2361x1568px · acquired with a Kowa VX-10α · pupil-dilated: 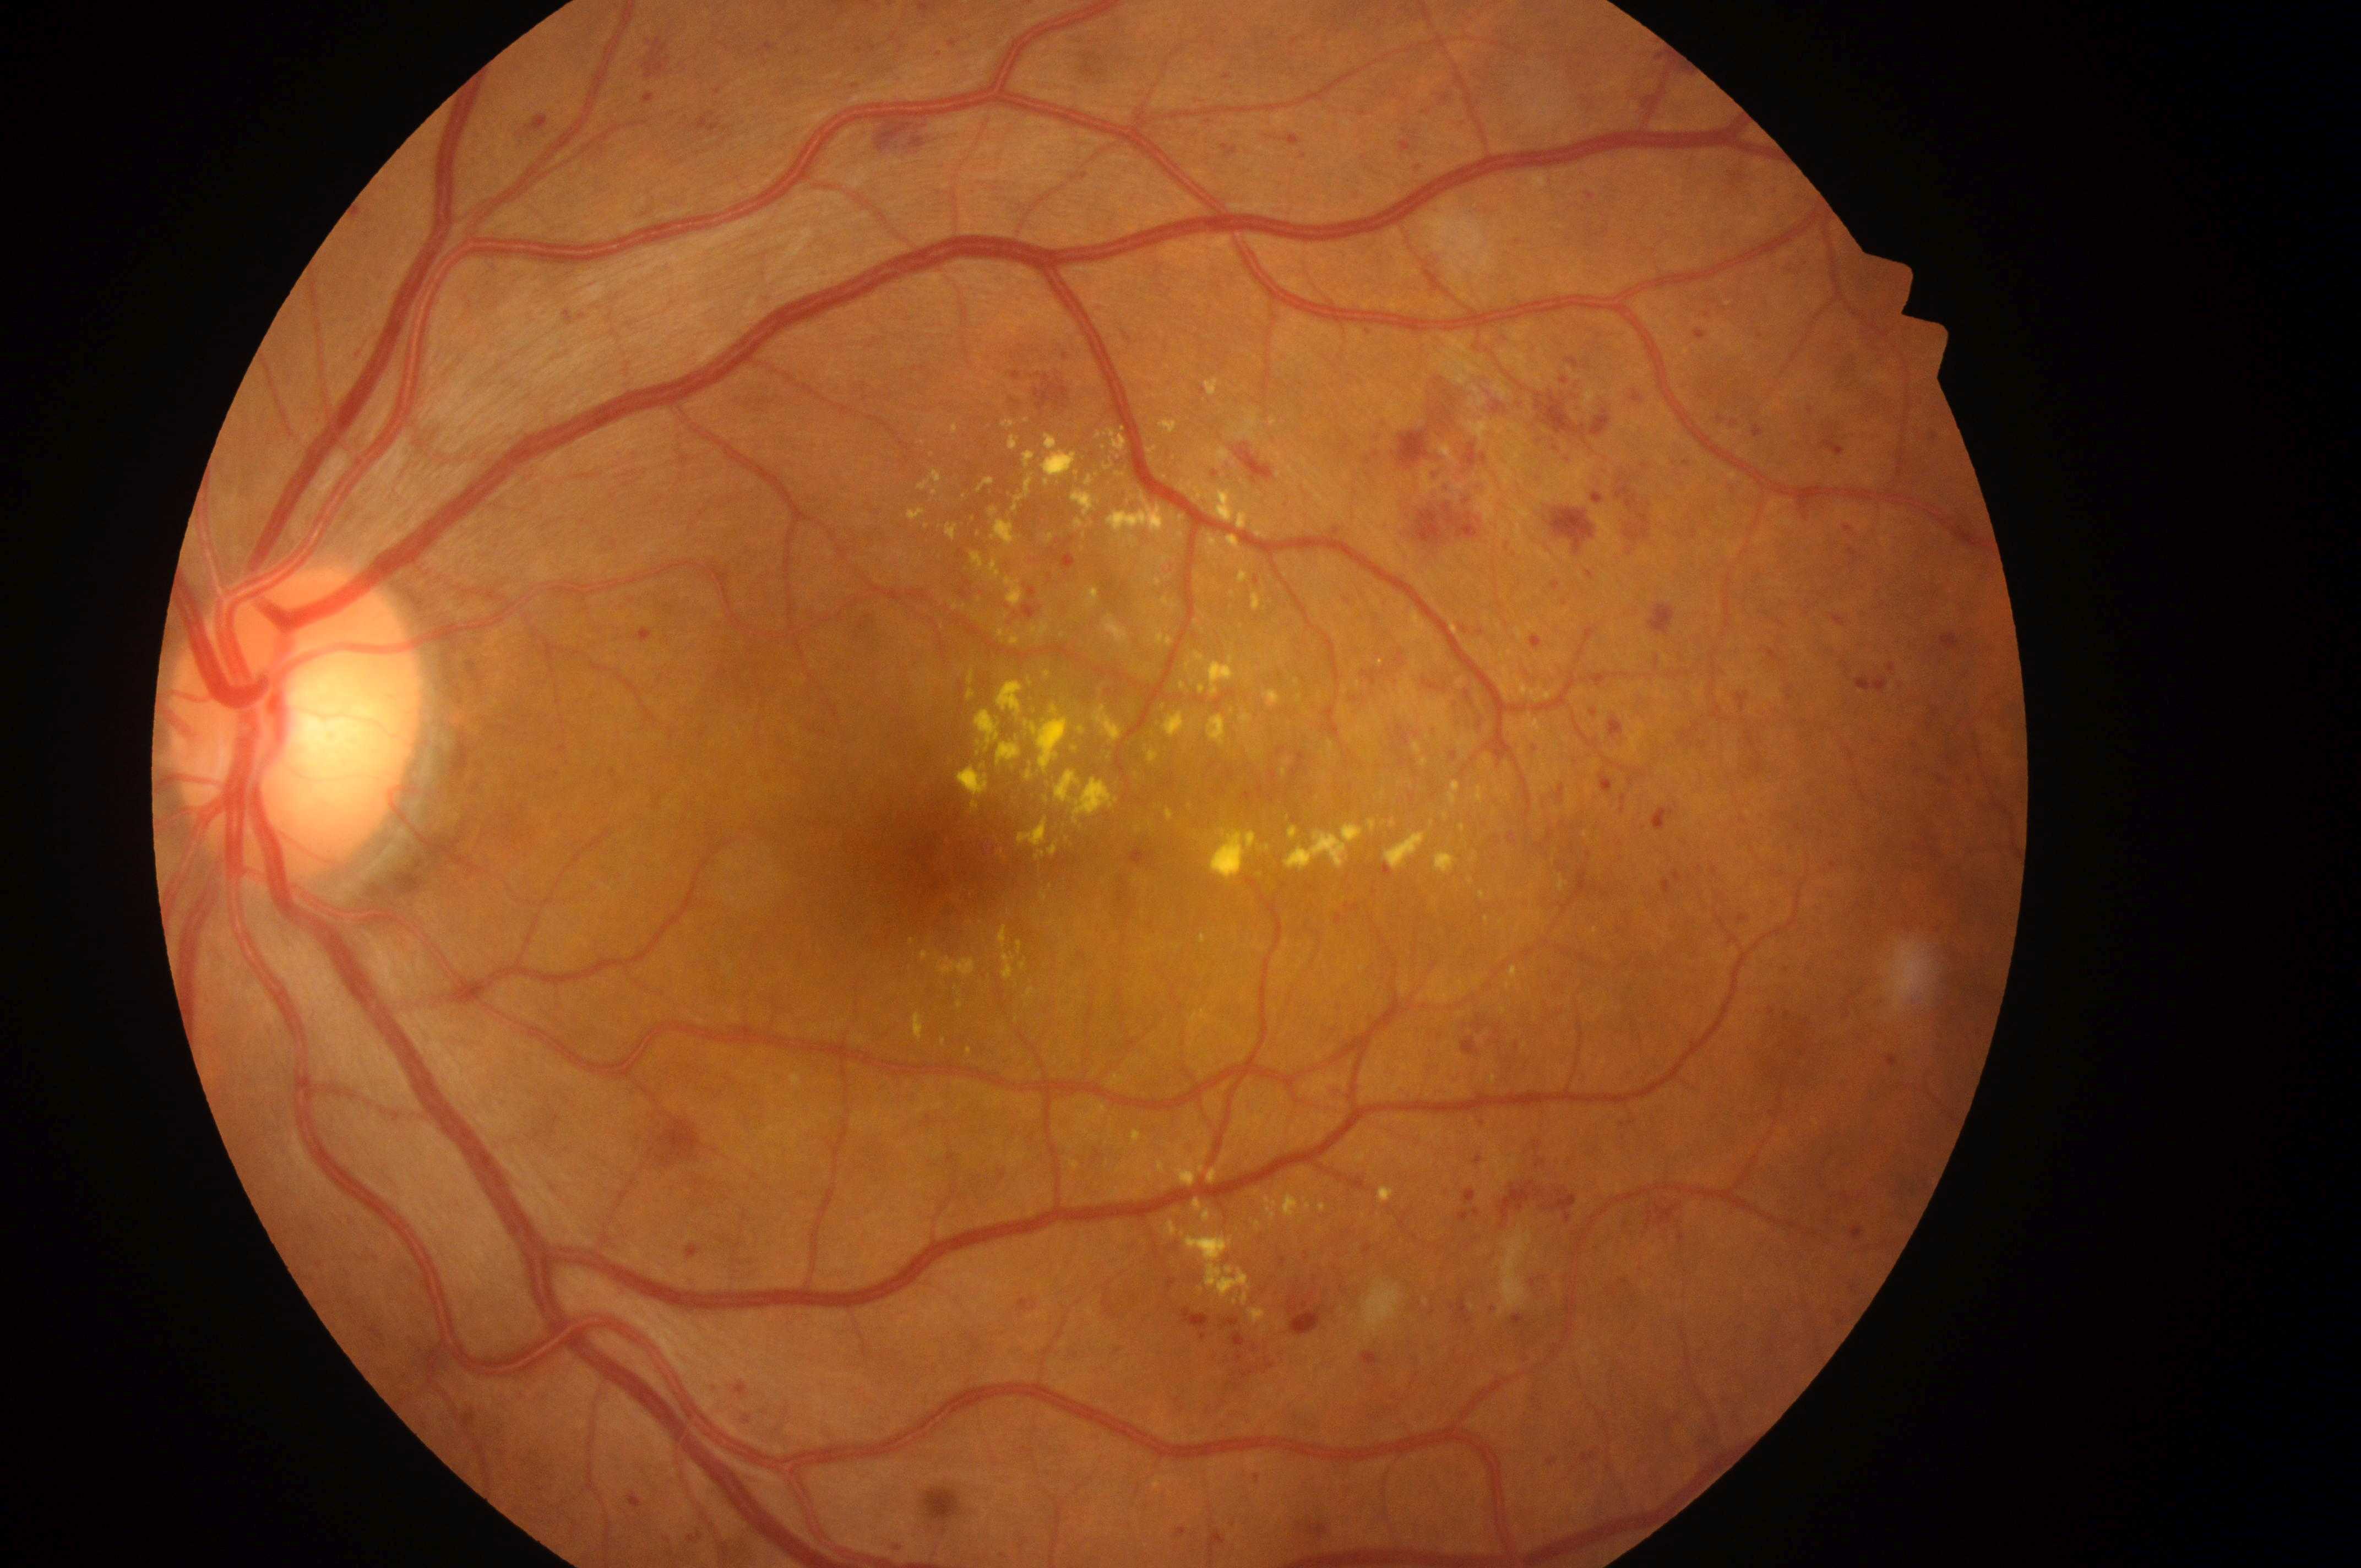
Findings:
– the optic disc: (x: 286, y: 738)
– macular edema risk: 2
– foveal center: (x: 938, y: 866)
– eye: OS
– retinopathy: 3/4